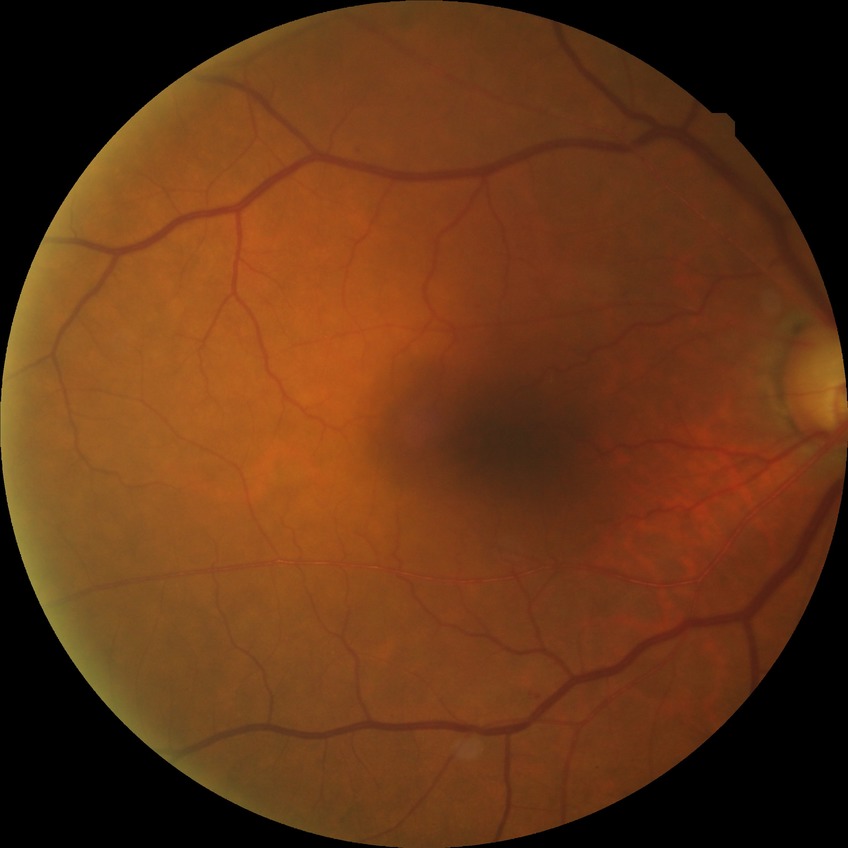 Retinopathy stage is no diabetic retinopathy.